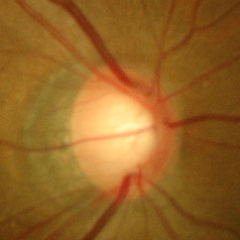 Q: What stage of glaucoma is present?
A: Yes — early glaucomatous optic neuropathy.